Color fundus photograph.
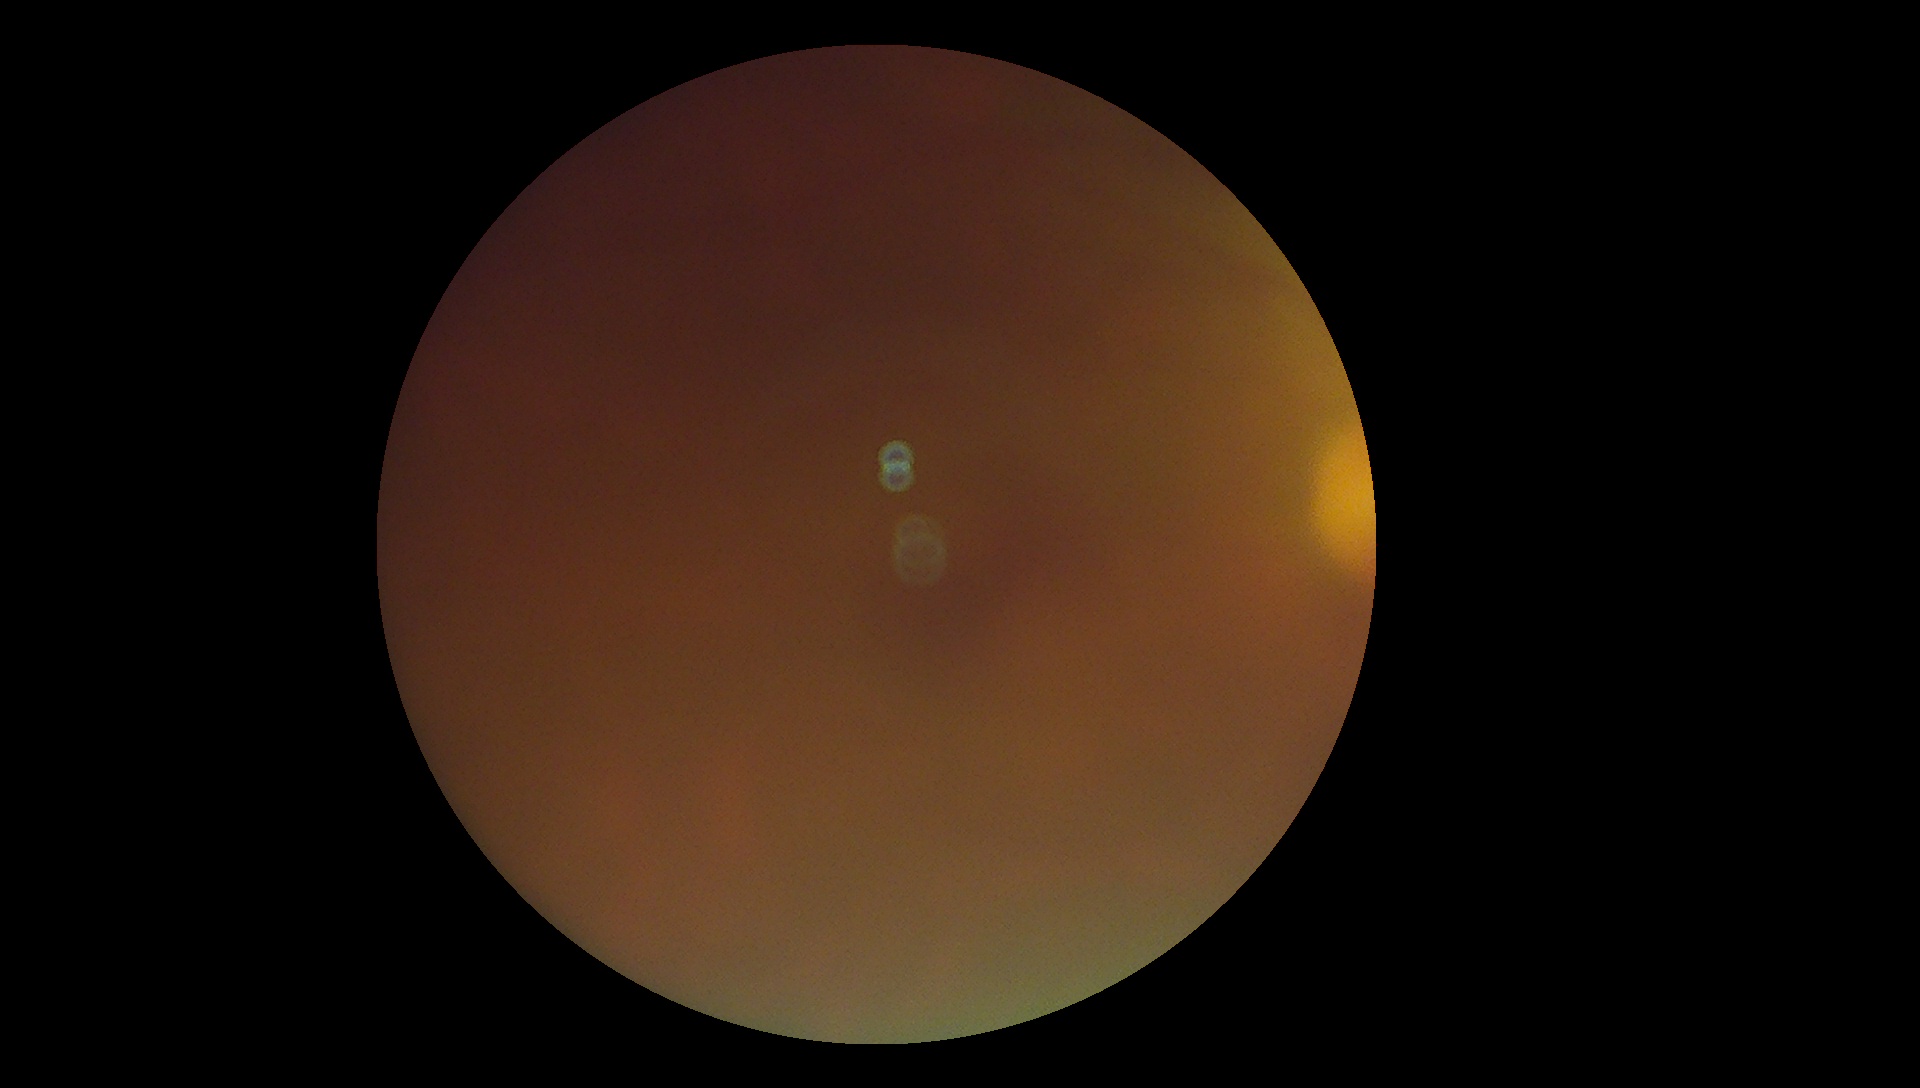

diabetic retinopathy severity: ungradable.